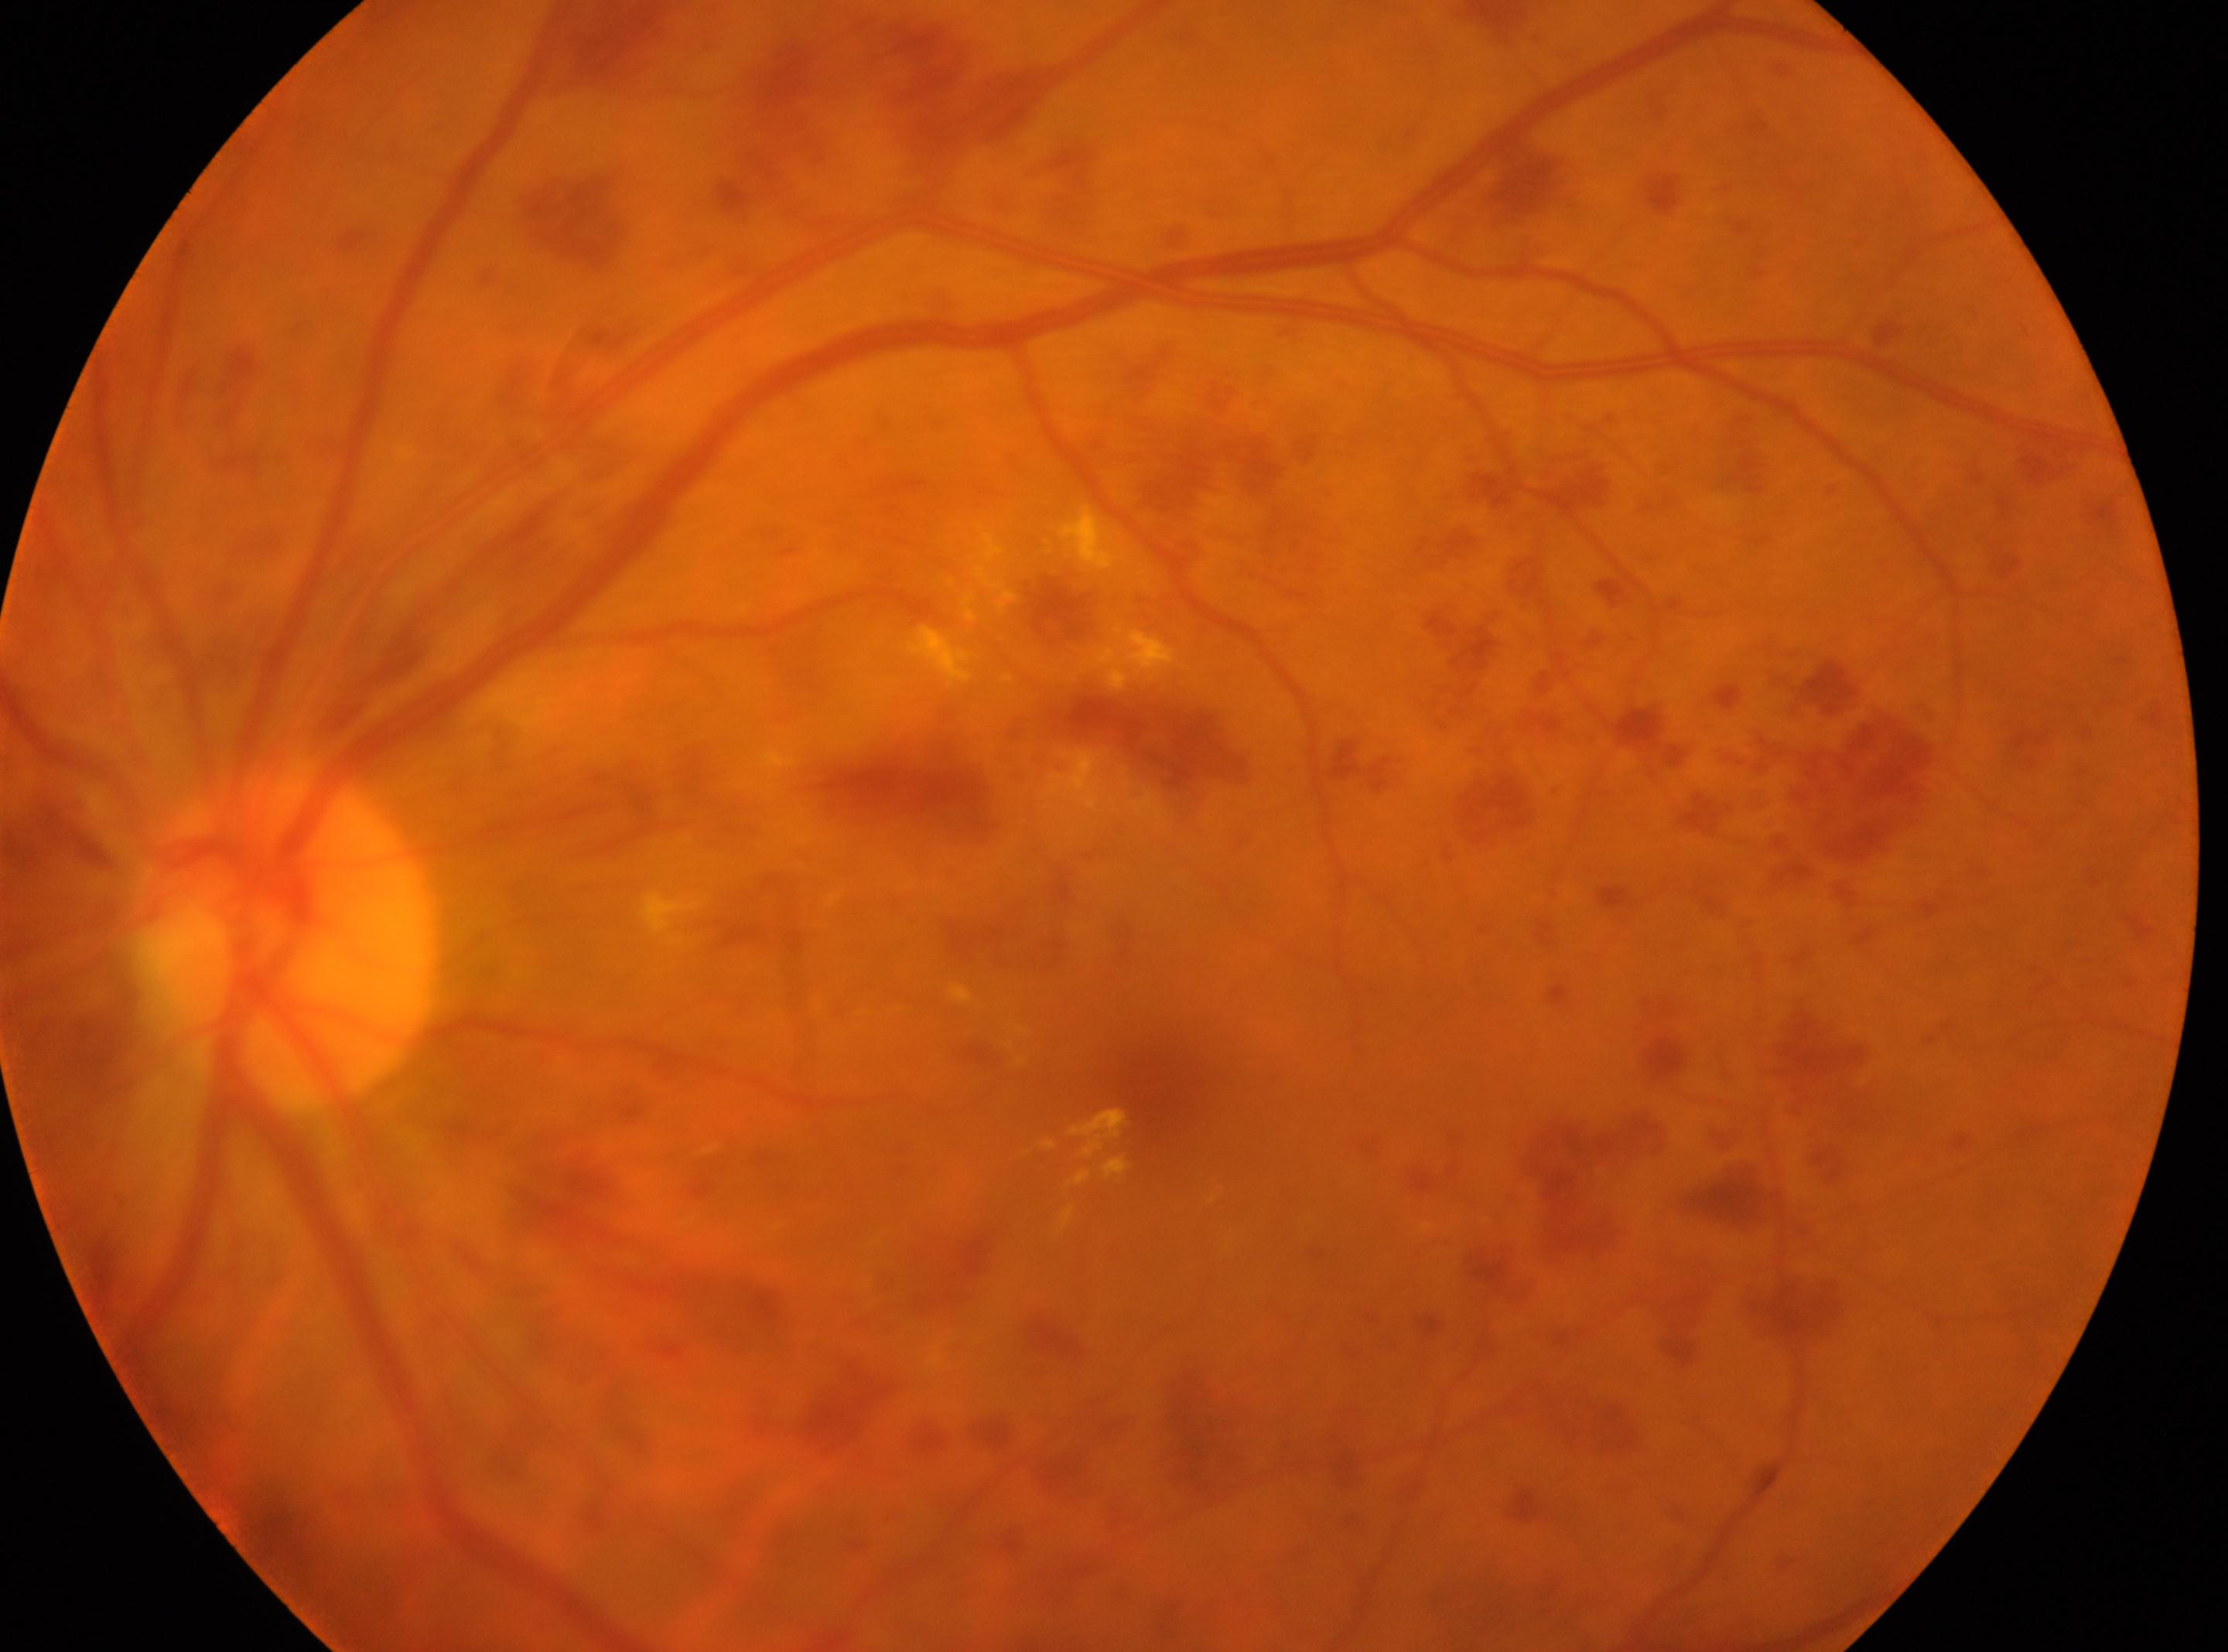

{"dr_grade": "severe NPDR (grade 3)", "eye": "the left eye", "optic_disc": "(x: 285, y: 939)", "fovea": "(x: 1153, y: 1070)"}